Posterior pole photograph
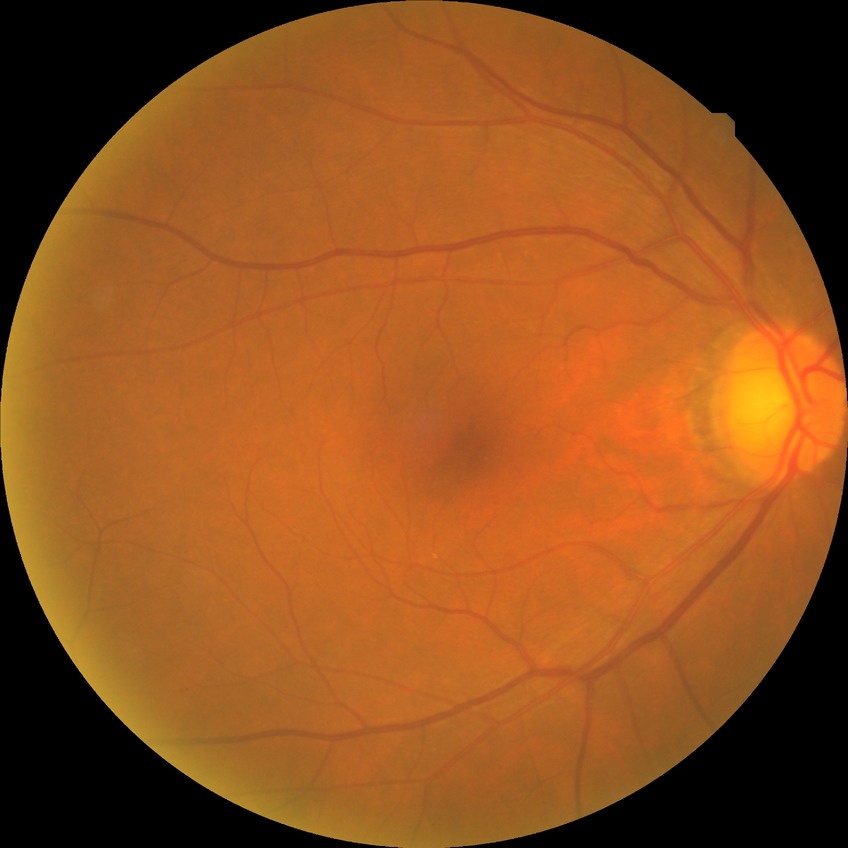
diabetic retinopathy (DR) = no diabetic retinopathy (NDR).